848 by 848 pixels, acquired with a NIDEK AFC-230, without pupil dilation, posterior pole photograph:
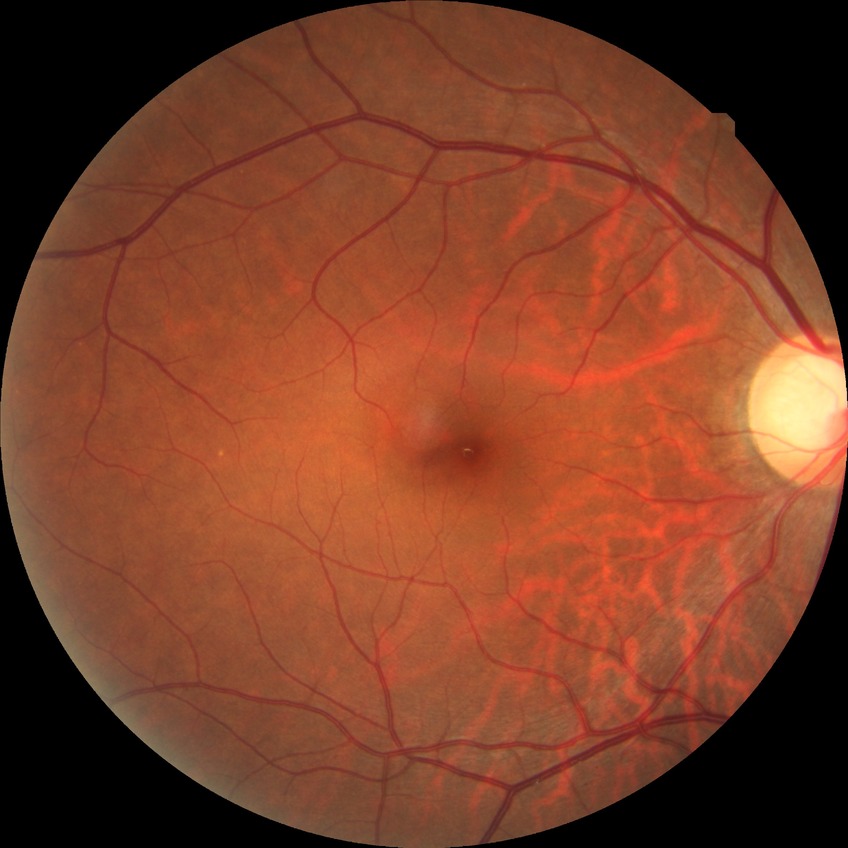
diabetic retinopathy (DR): no diabetic retinopathy (NDR).